45 degree fundus photograph; DR severity per modified Davis staging; fundus photo
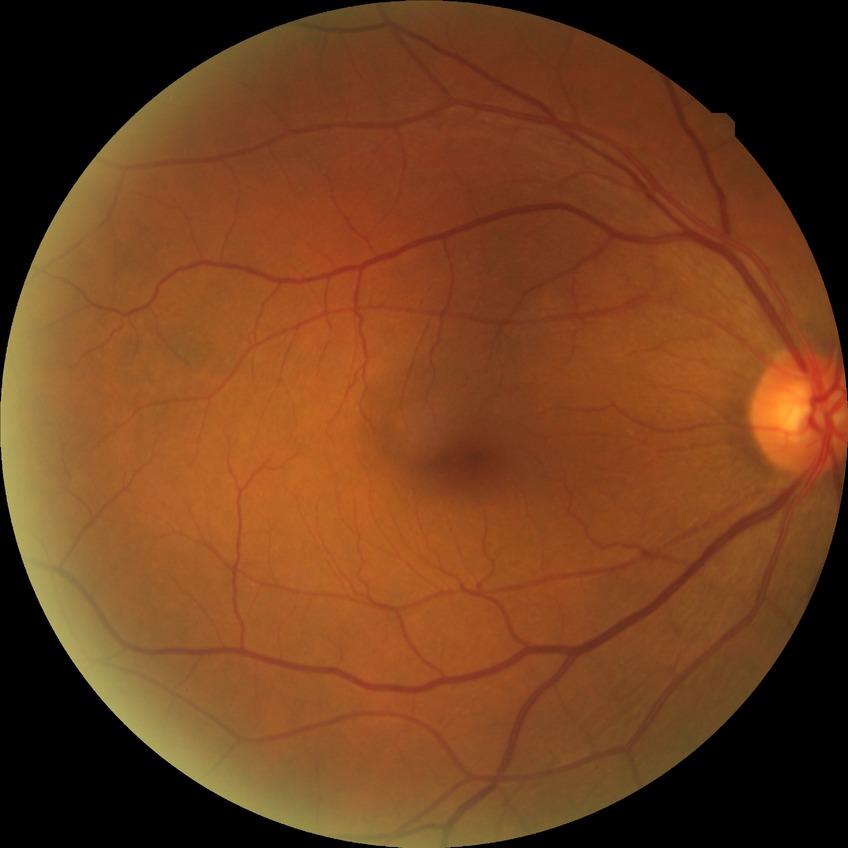

{
  "davis_grade": "no diabetic retinopathy (NDR)"
}